Color fundus photograph · FOV: 45 degrees · image size 2346x1568: 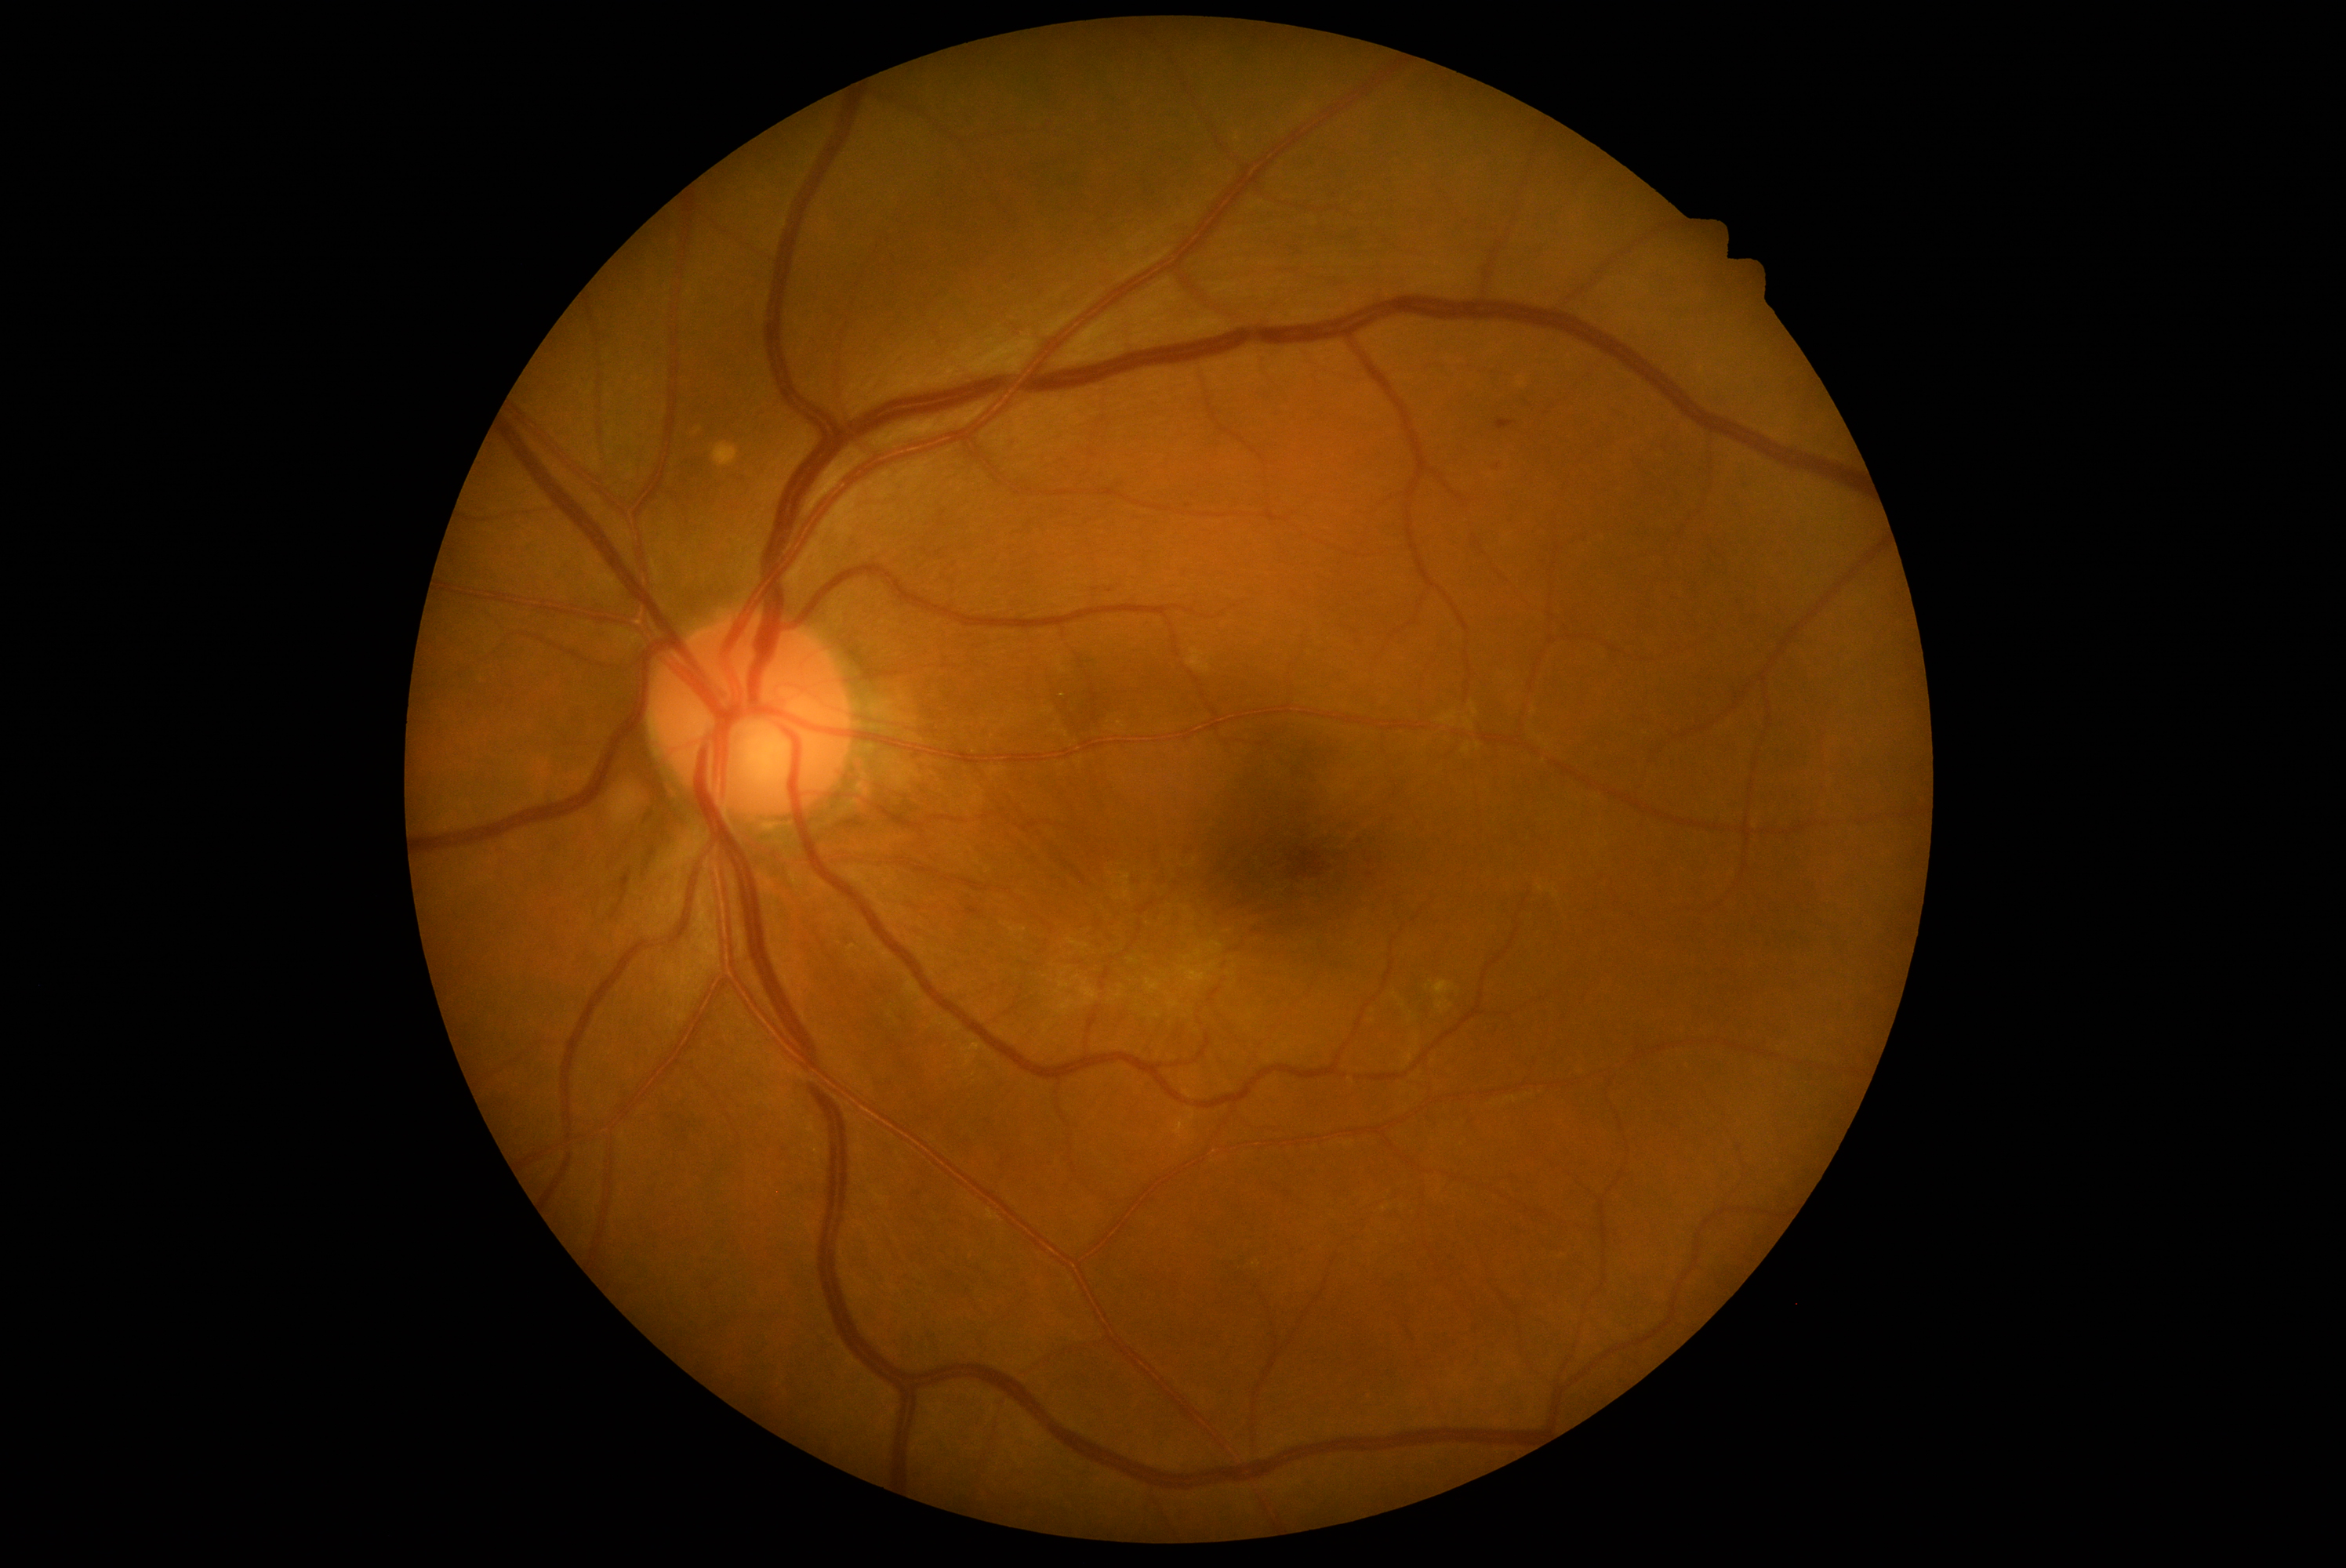

DR is grade 2 (moderate NPDR) — more than just microaneurysms but less than severe NPDR.